Camera: Phoenix ICON (100° FOV). Wide-field contact fundus photograph of an infant.
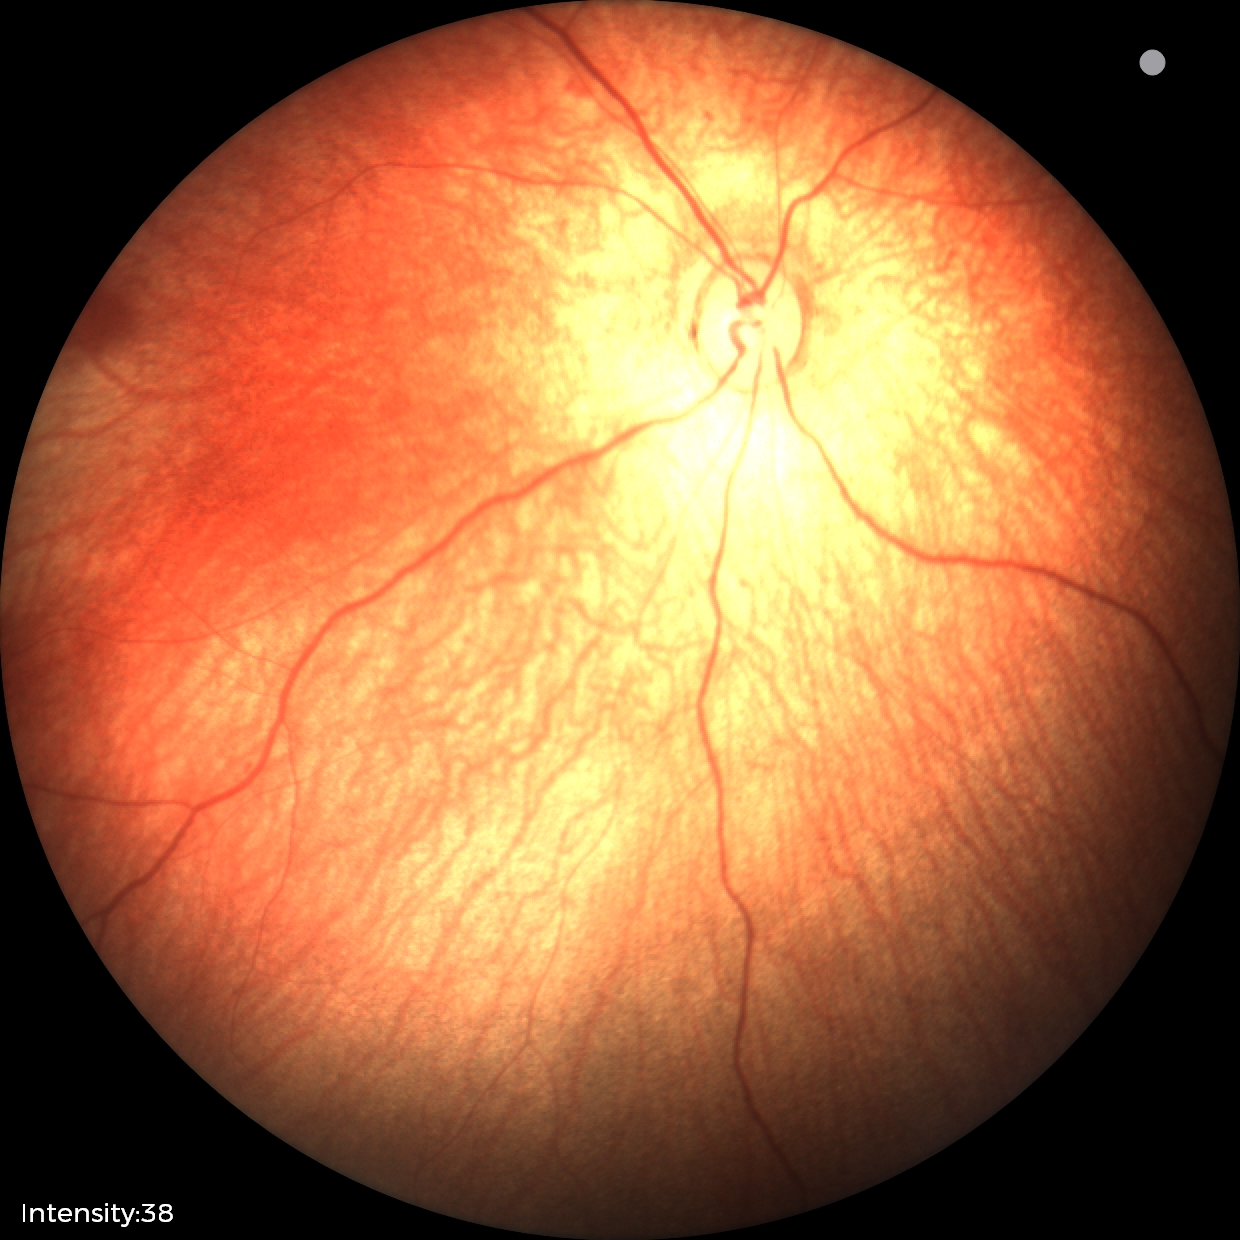 Screening examination diagnosed as physiological.